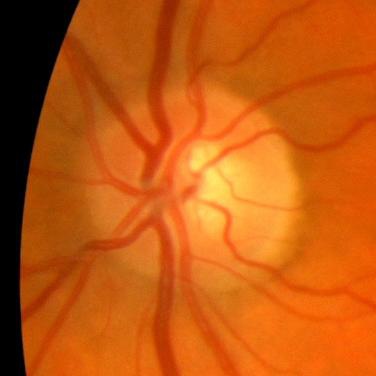 The image shows no glaucomatous findings.